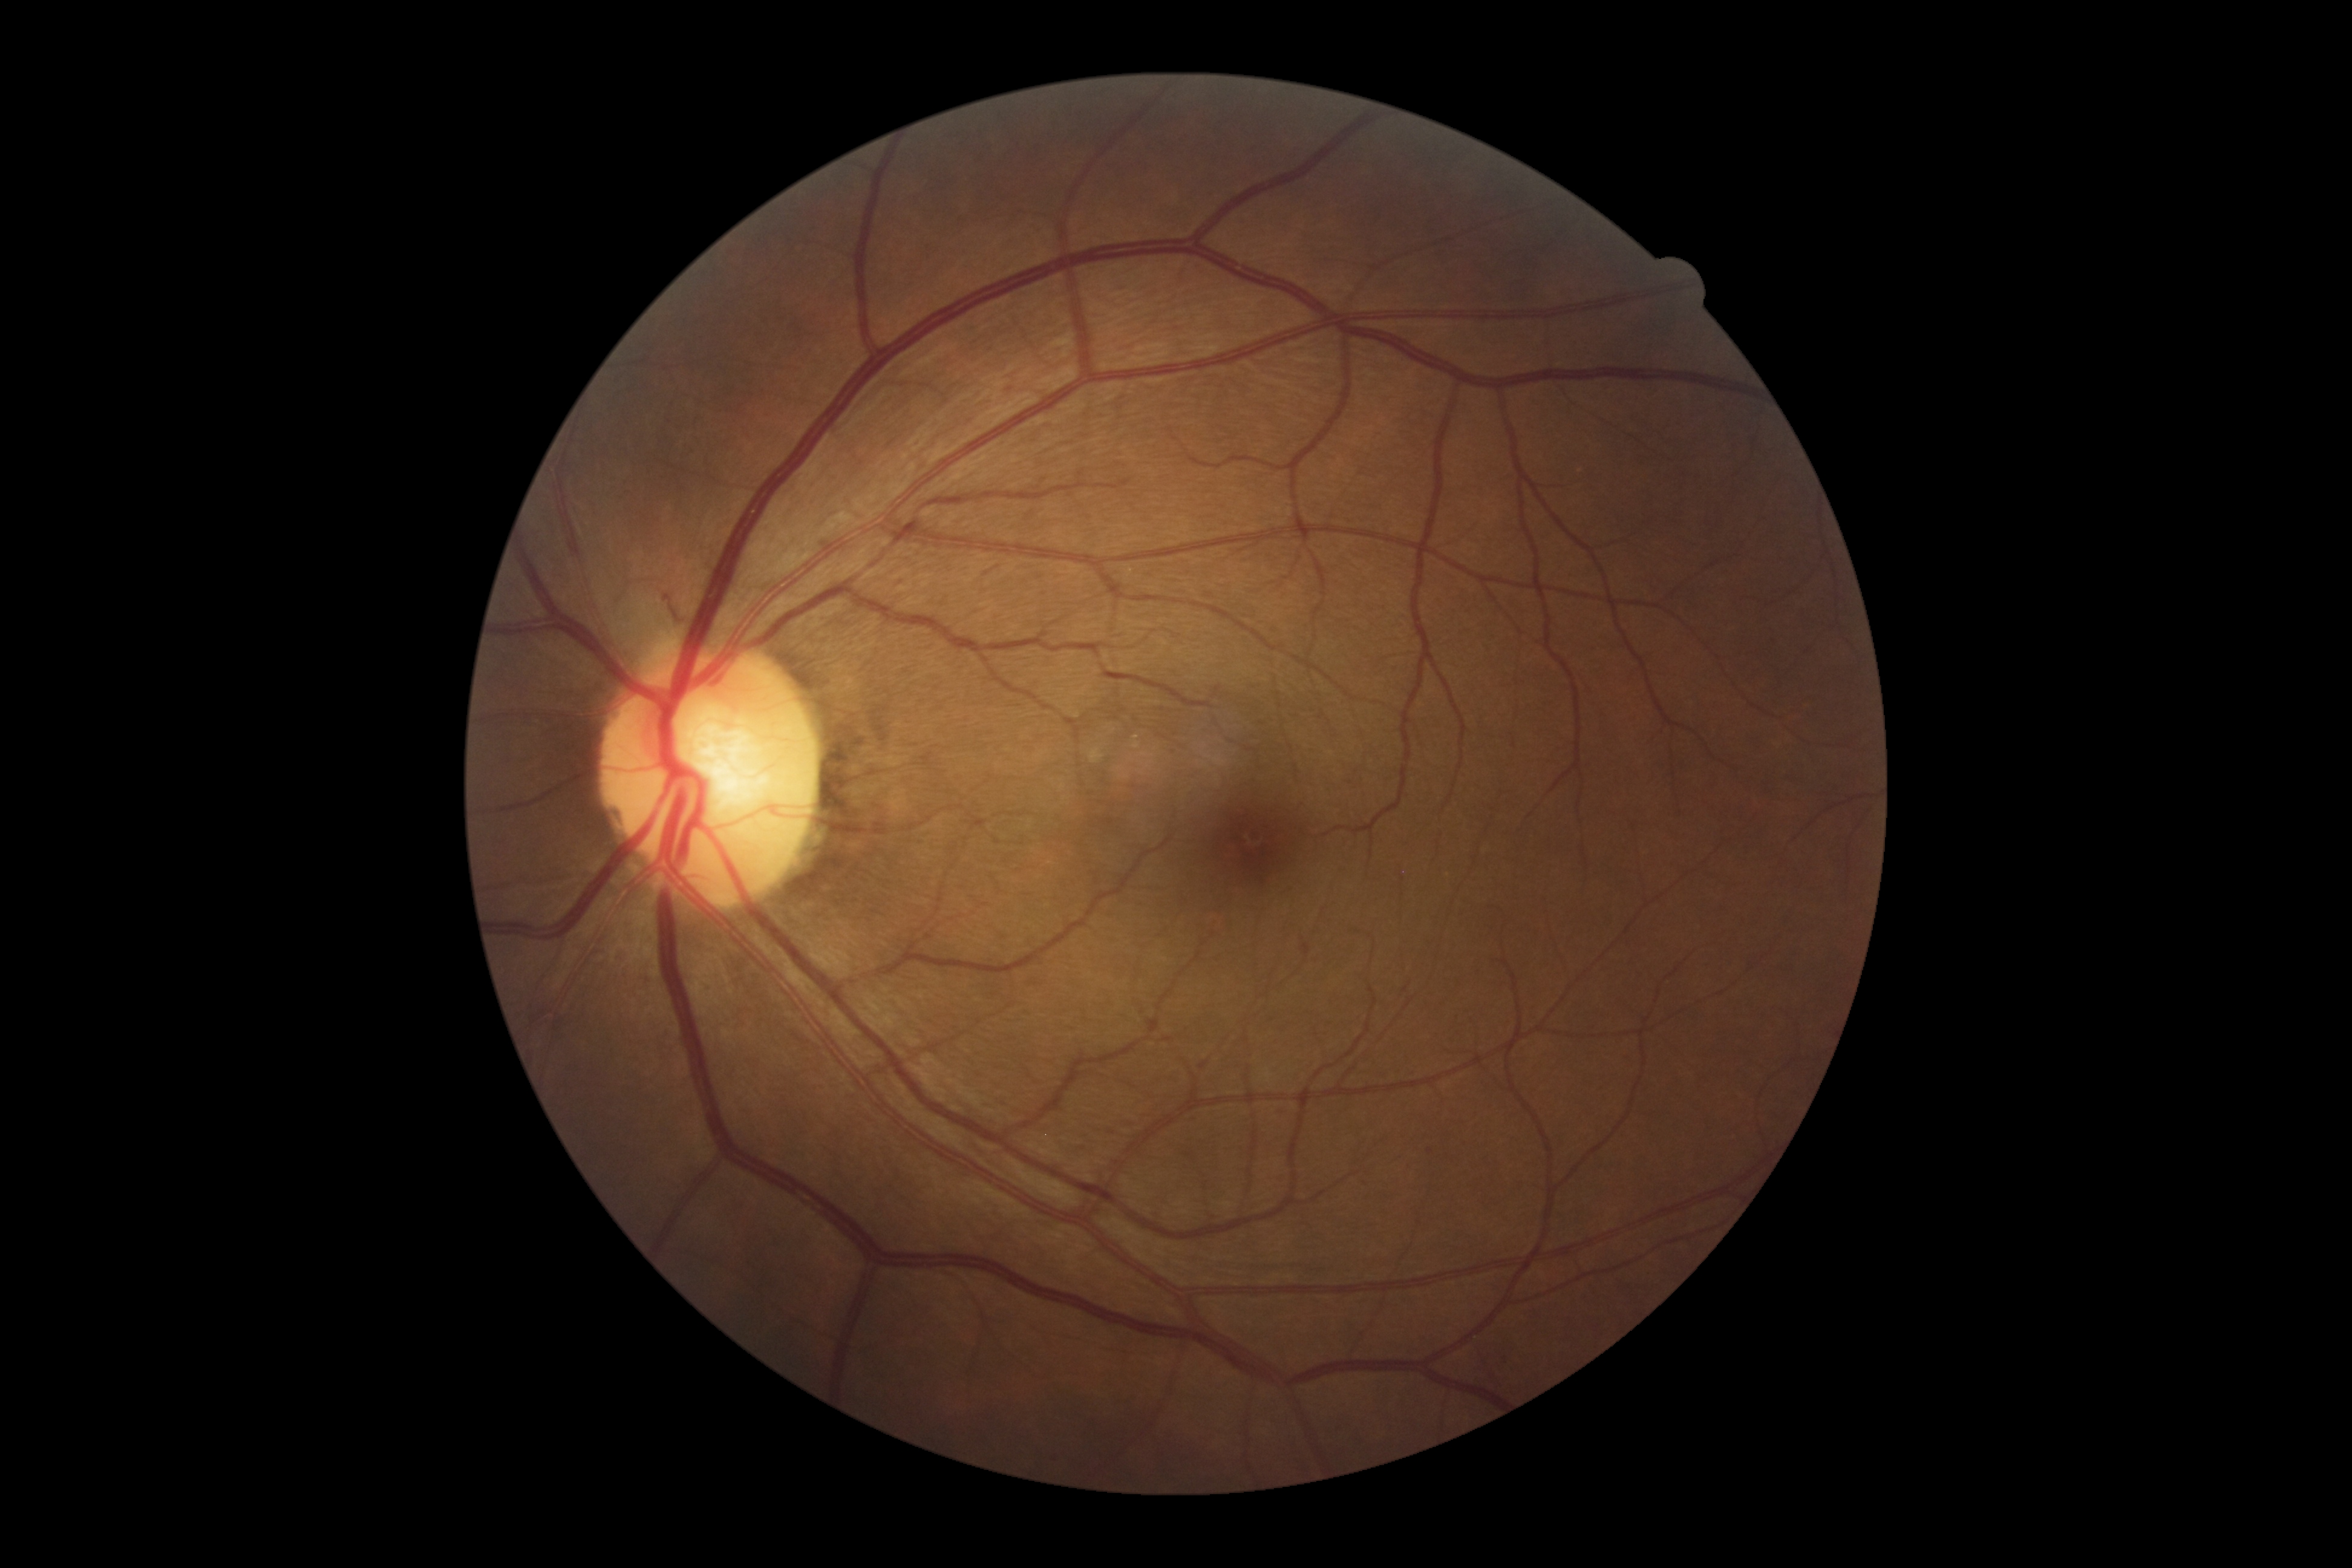
DR: 2 — more than just microaneurysms but less than severe NPDR.